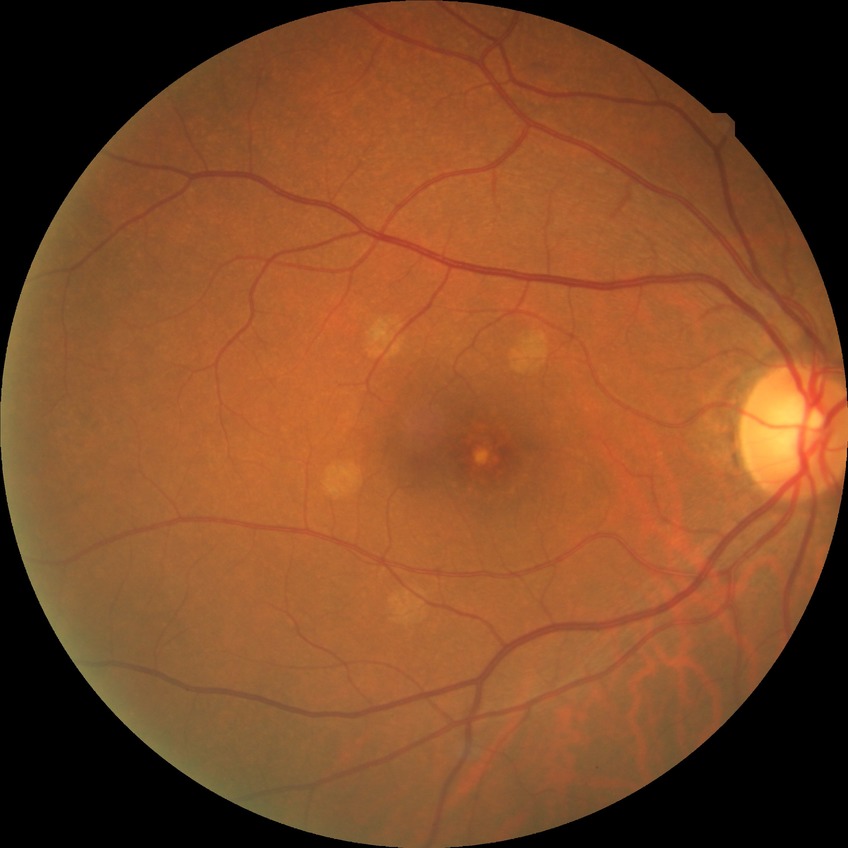 diabetic retinopathy (DR)=no diabetic retinopathy (NDR).